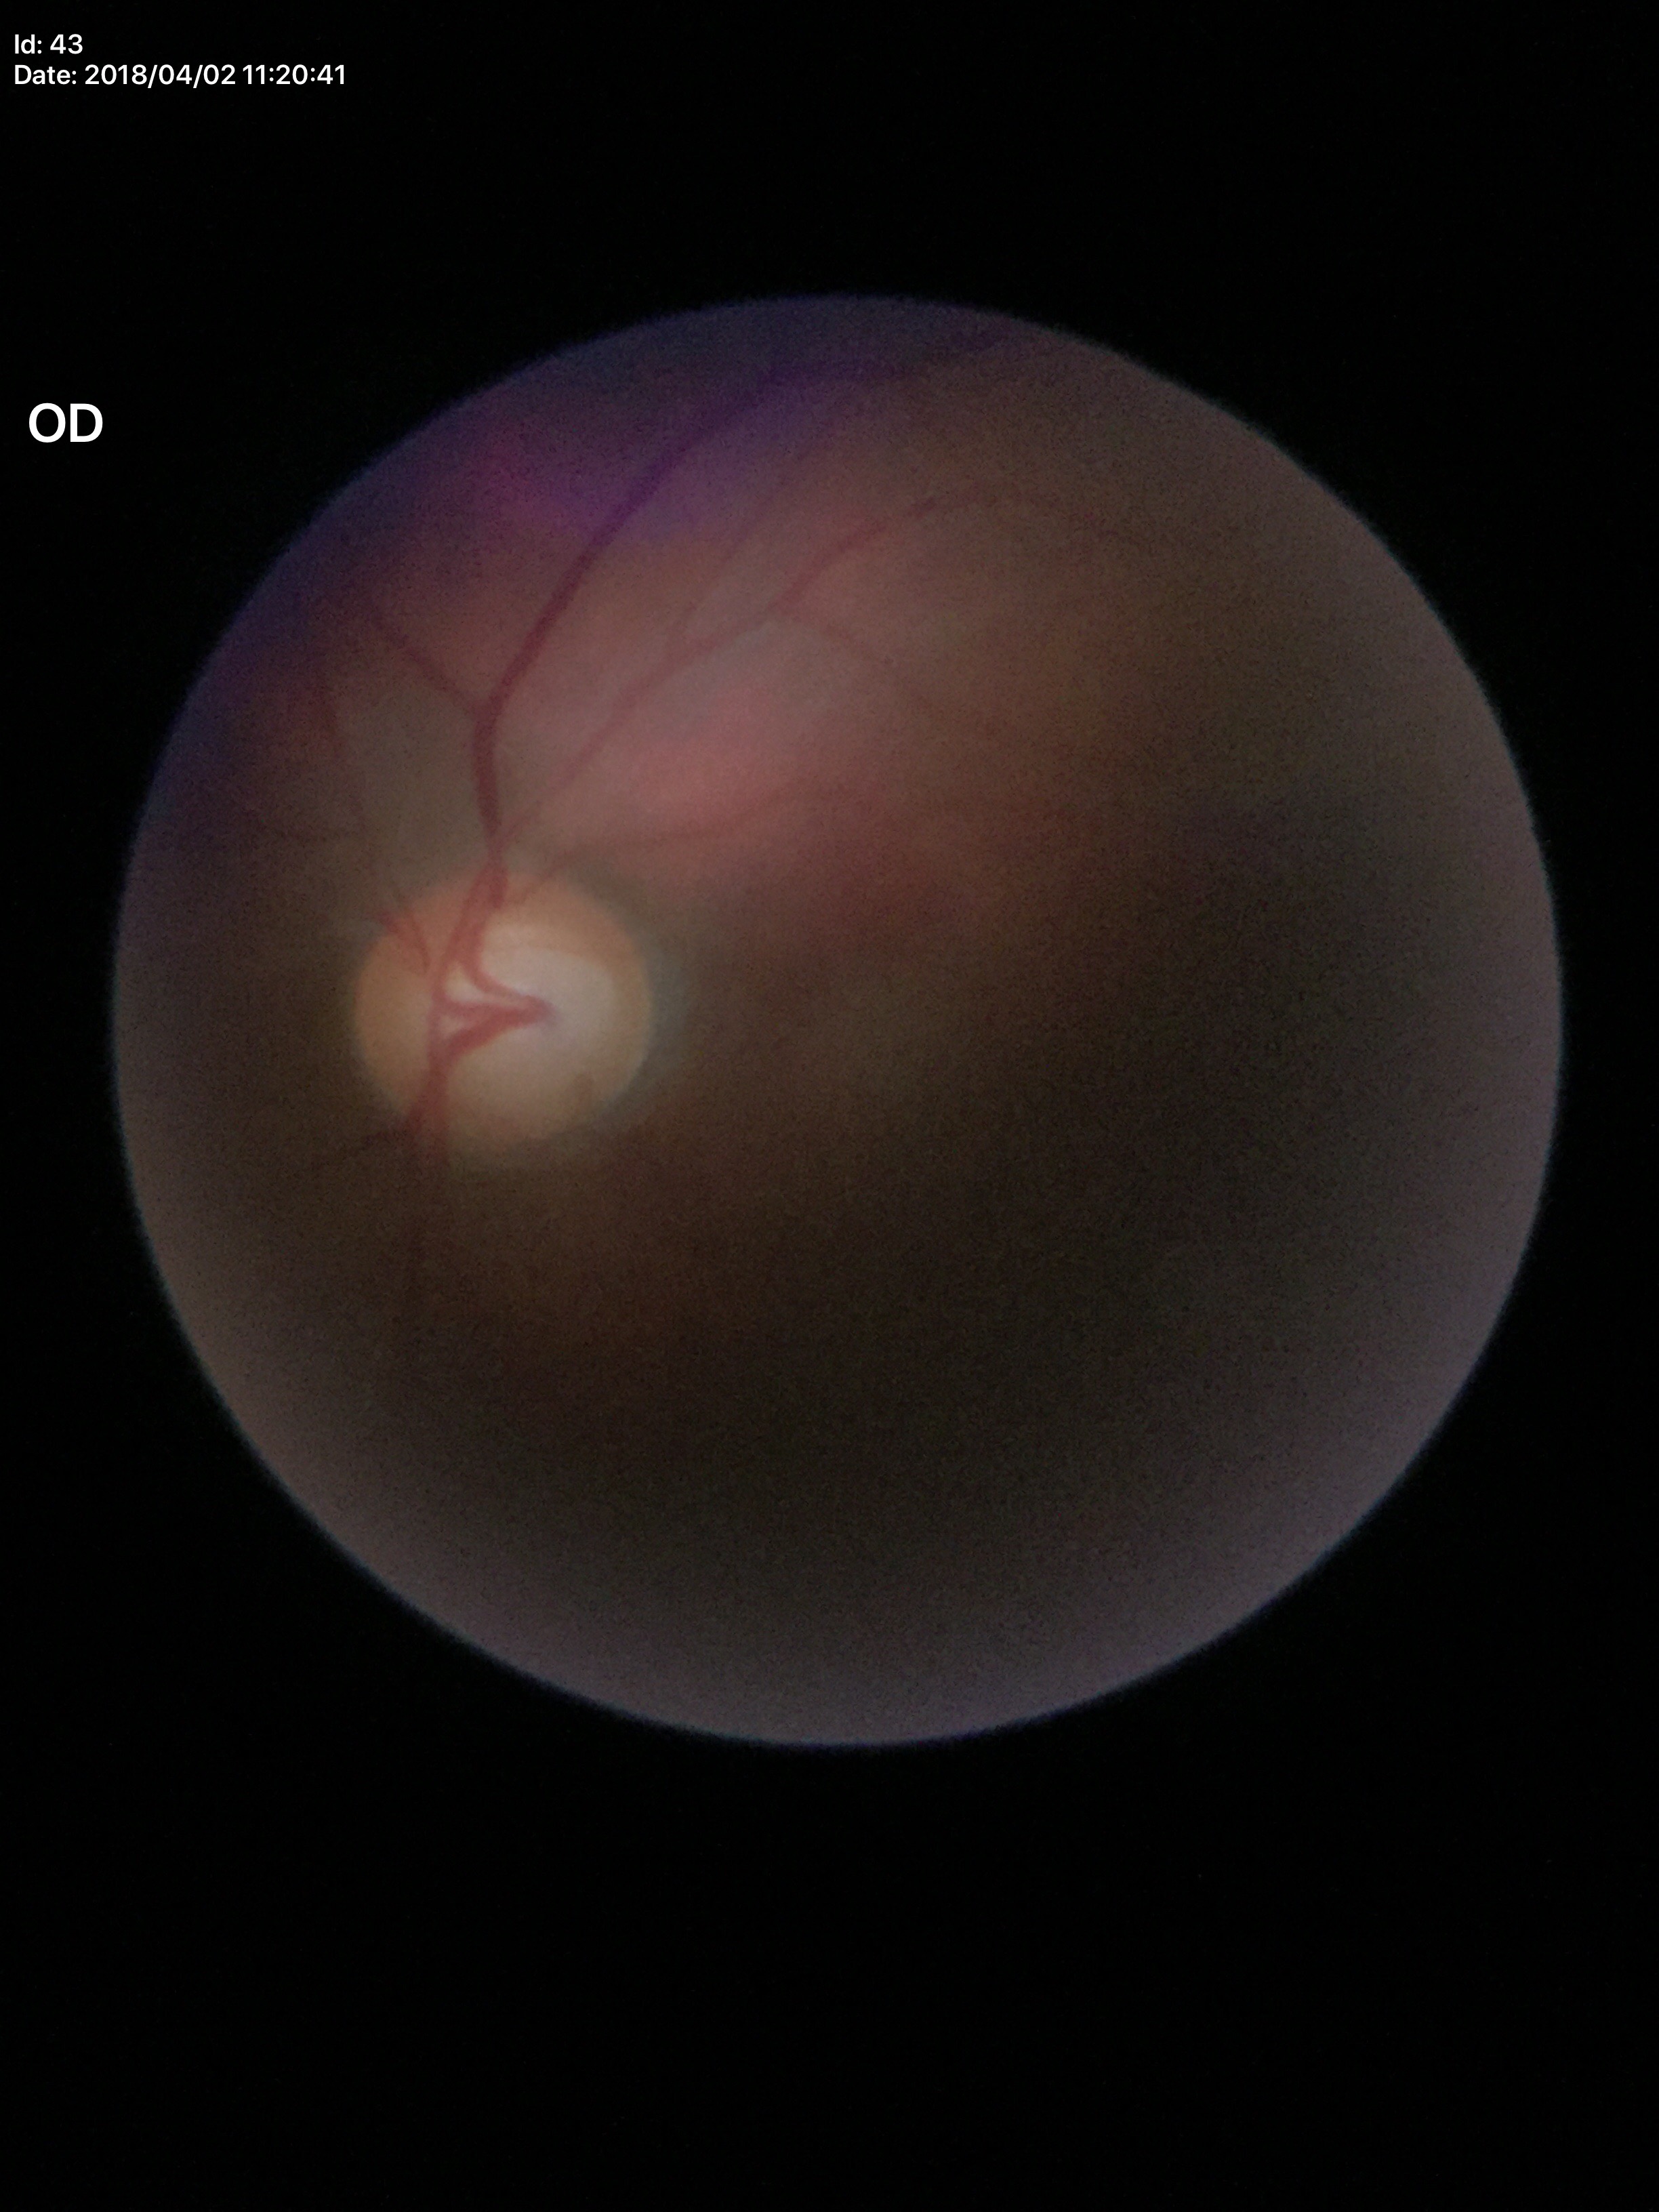
Vertical cup-disc ratio (VCDR) is 0.67. Glaucoma evaluation: suspicious. Horizontal C/D ratio (HCDR): 0.67.